Acquired with a NIDEK AFC-230, color fundus image, 848x848, without pupil dilation: 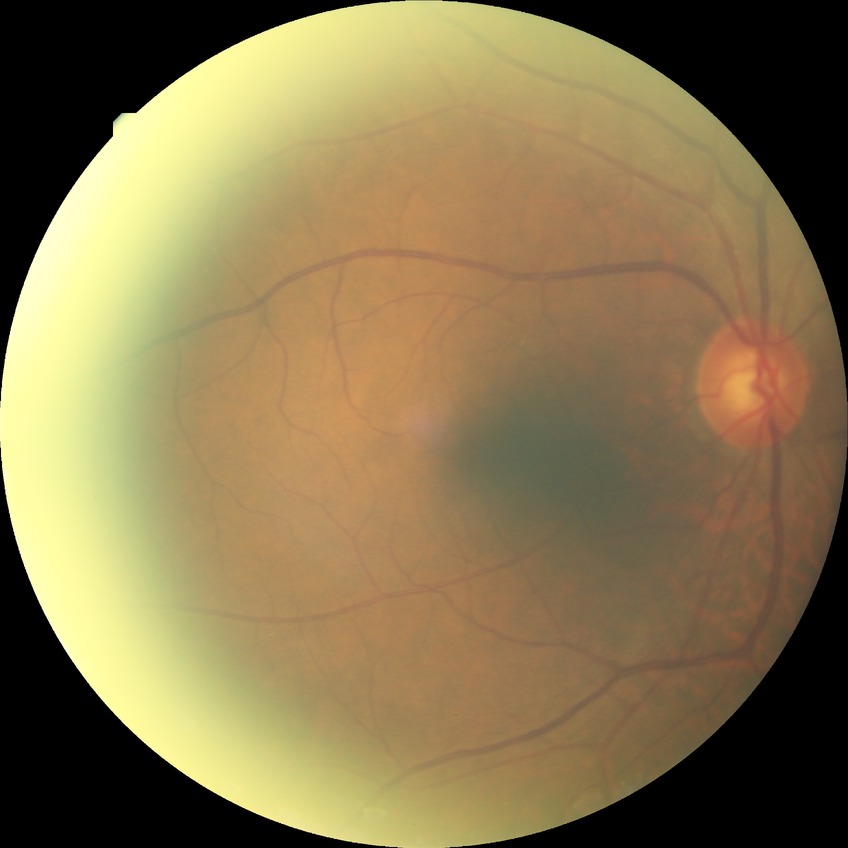

Diabetic retinopathy (DR) is NDR (no diabetic retinopathy).